Camera: NIDEK AFC-230, 848 by 848 pixels, nonmydriatic fundus photograph: 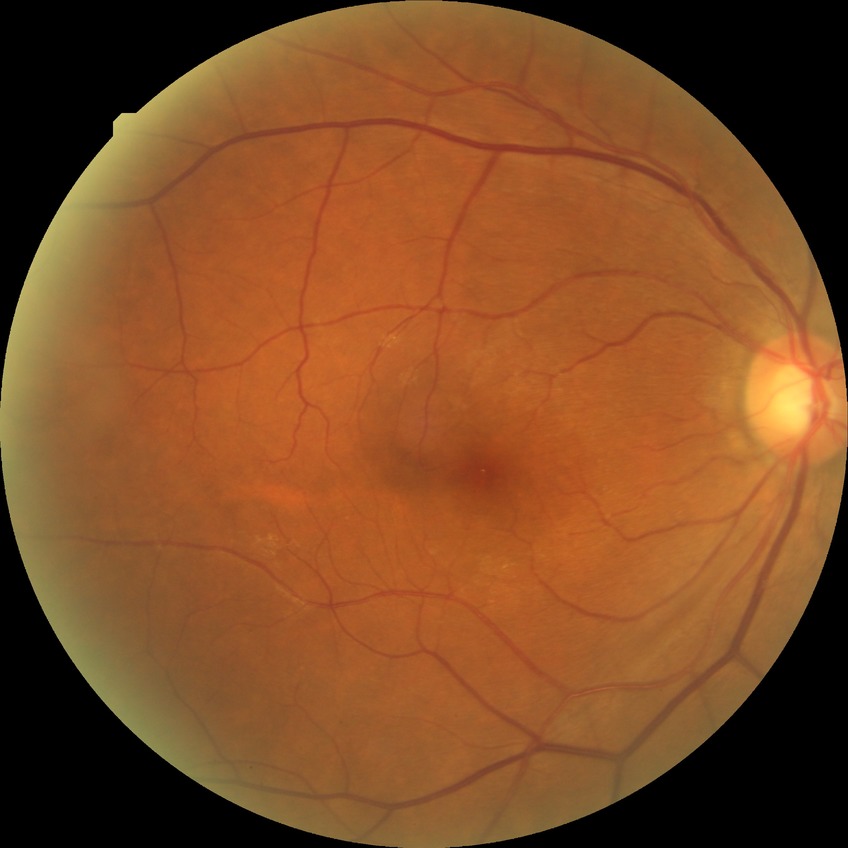
Annotations:
- diabetic retinopathy grade — no diabetic retinopathy